FOV: 45 degrees; 848 by 848 pixels — 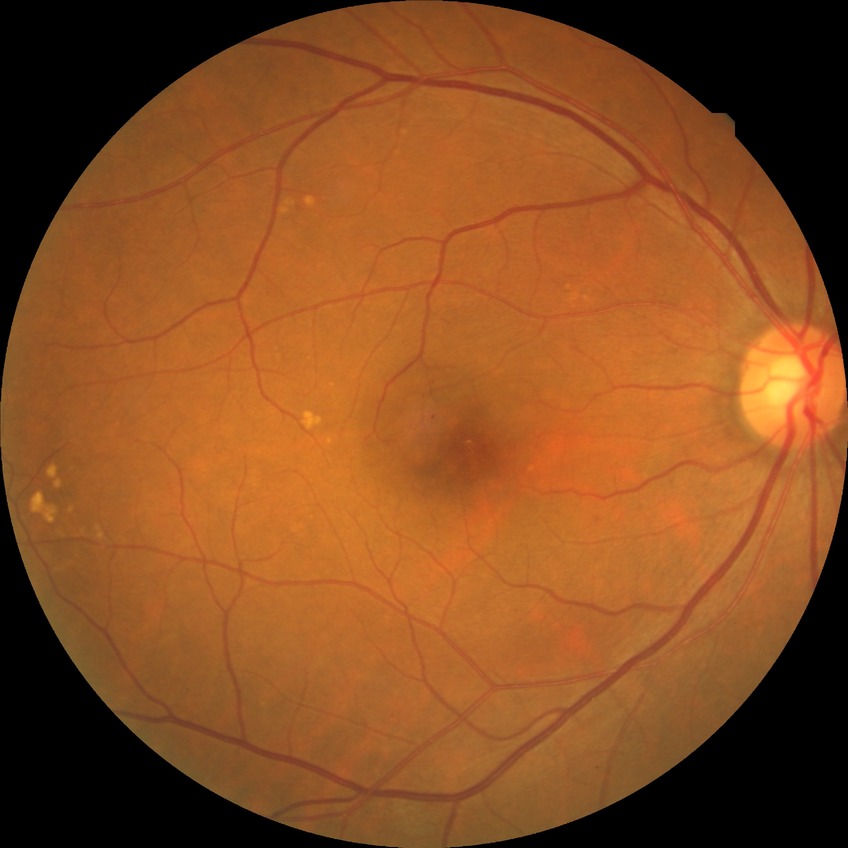

diabetic retinopathy (DR): simple diabetic retinopathy (SDR), DR class: non-proliferative diabetic retinopathy.